Nonmydriatic; camera: NIDEK AFC-230; FOV: 45 degrees.
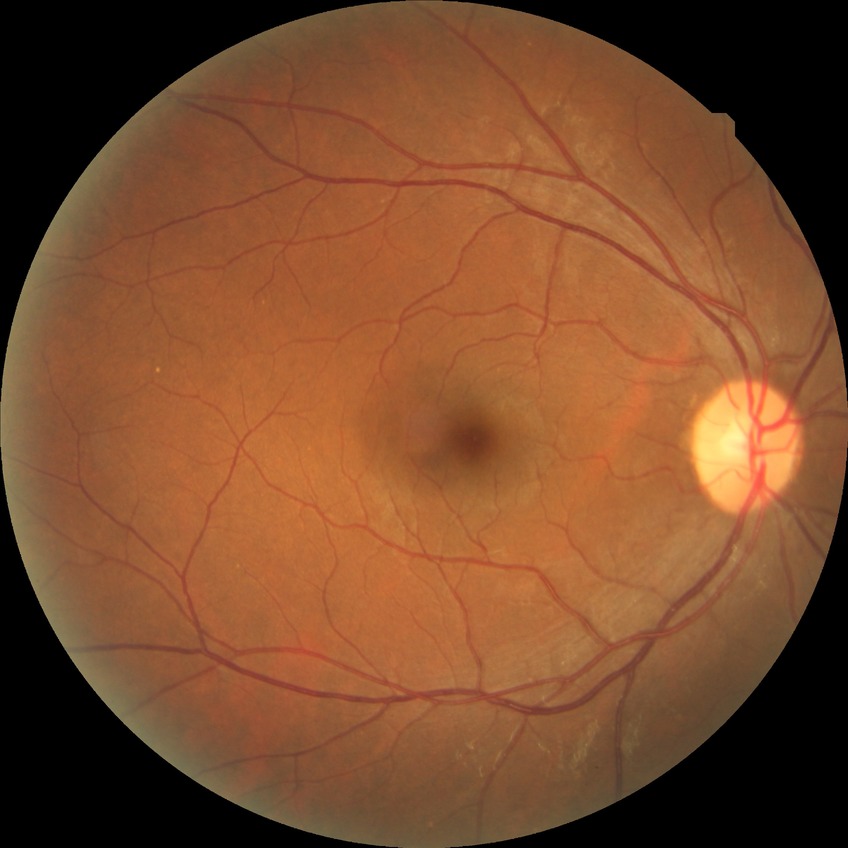

Findings:
* retinopathy grade — no diabetic retinopathy